Without pupil dilation · modified Davis grading.
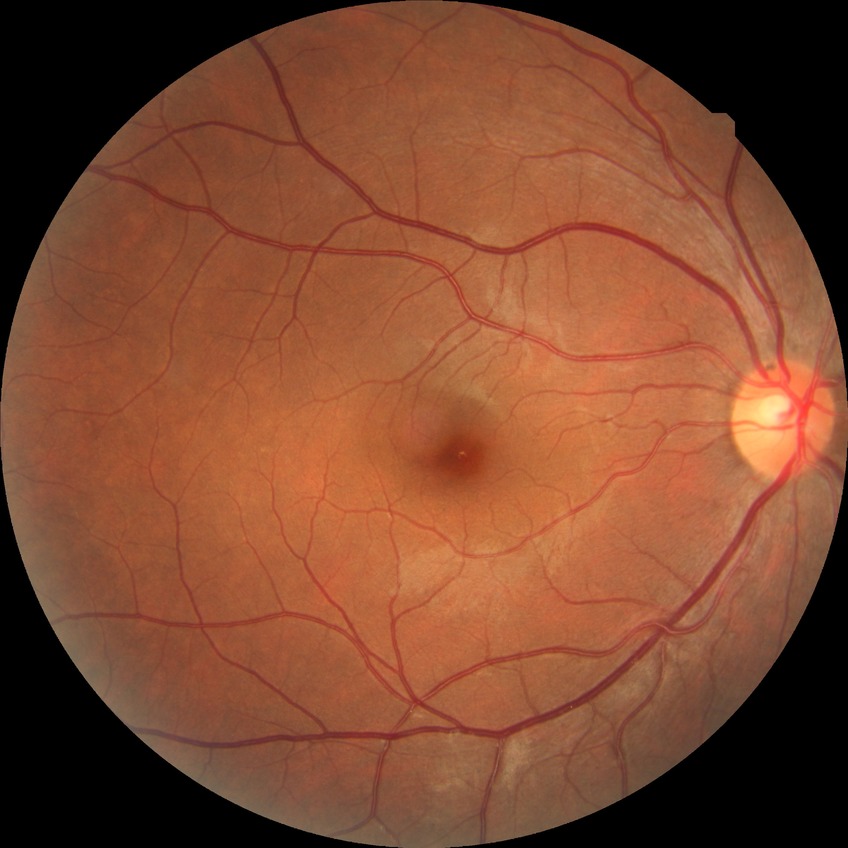

diabetic retinopathy (DR): no diabetic retinopathy (NDR).